Nonmydriatic fundus photograph
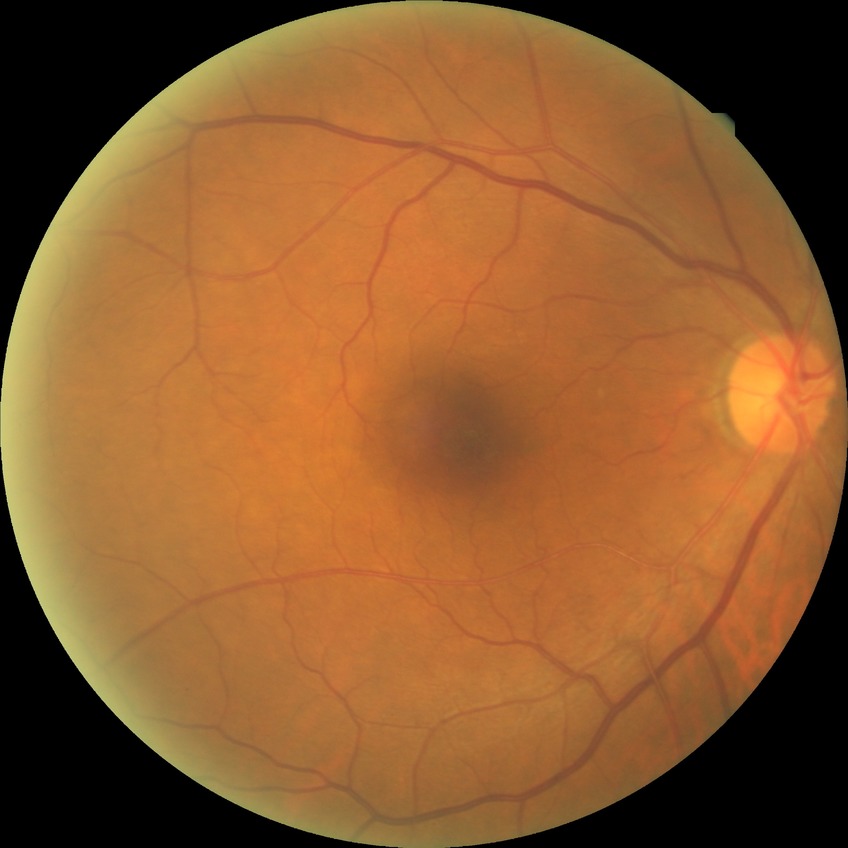
Modified Davis classification: no diabetic retinopathy.